Graded on the modified Davis scale
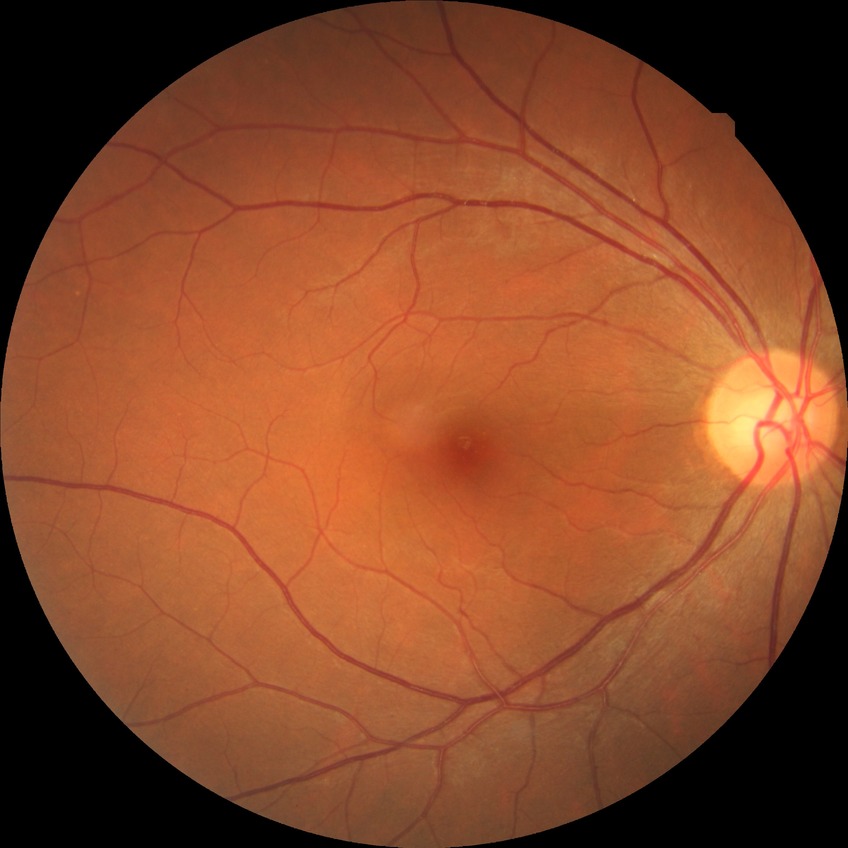 retinopathy stage@no diabetic retinopathy.